NIDEK AFC-230. Nonmydriatic. Diabetic retinopathy graded by the modified Davis classification: 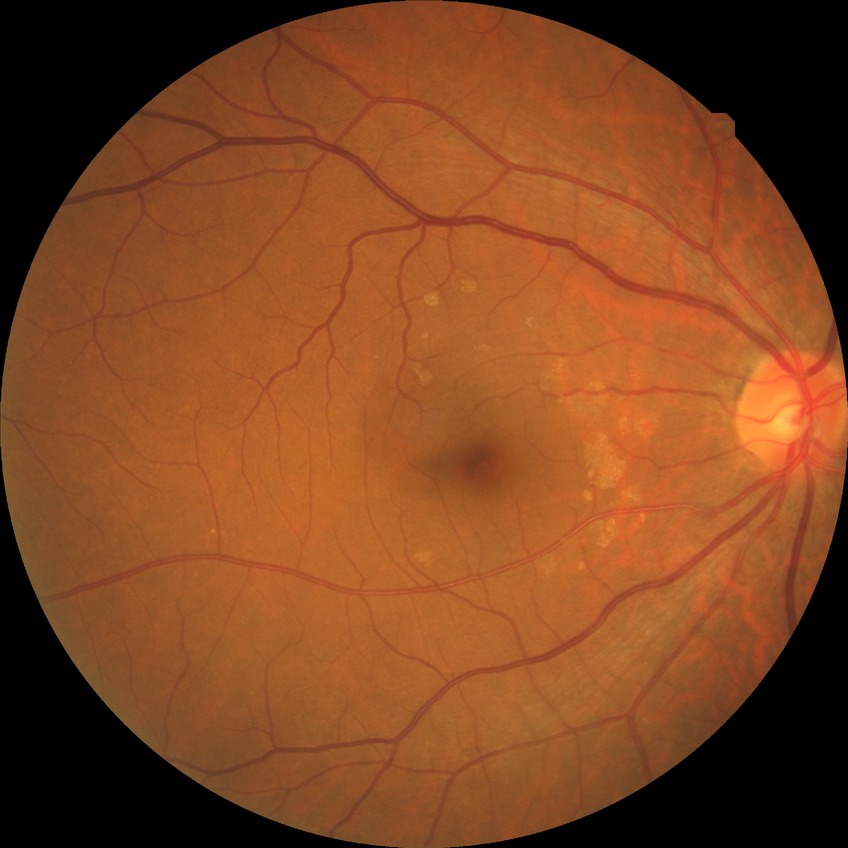 Diabetic retinopathy (DR): NDR (no diabetic retinopathy).